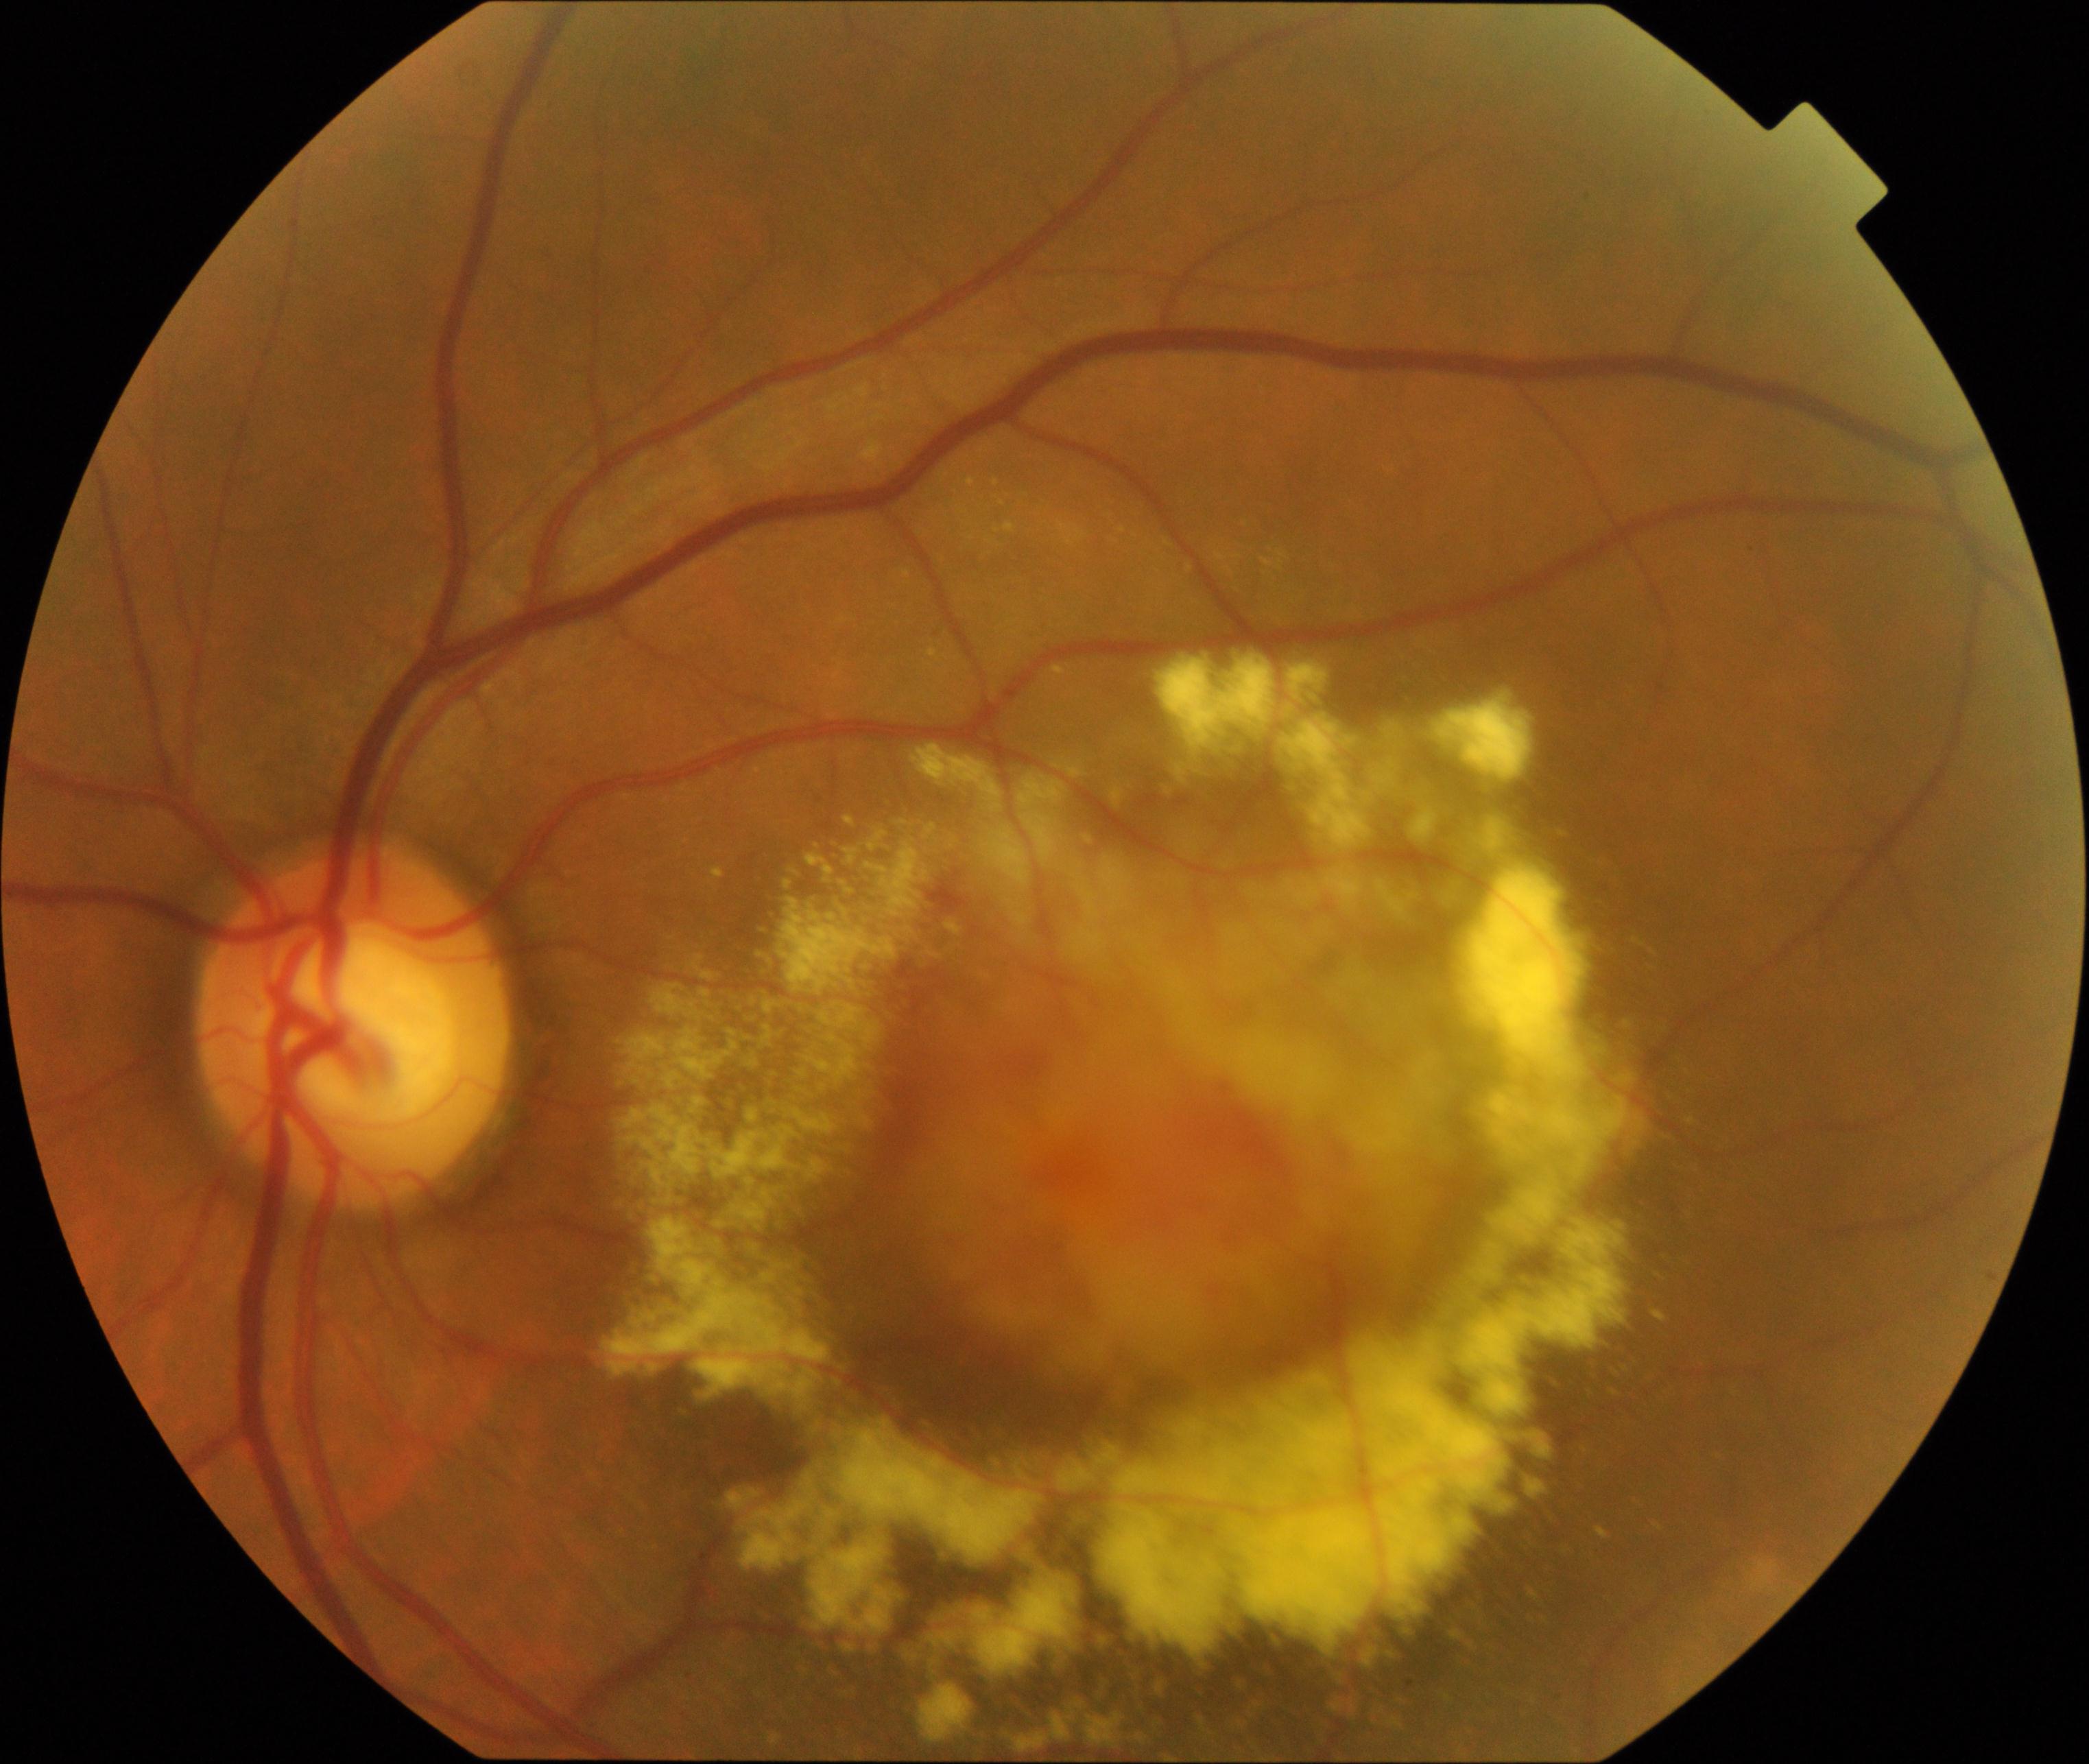 Consistent with maculopathy.